CFP; 848 x 848 pixels; nonmydriatic fundus photograph — 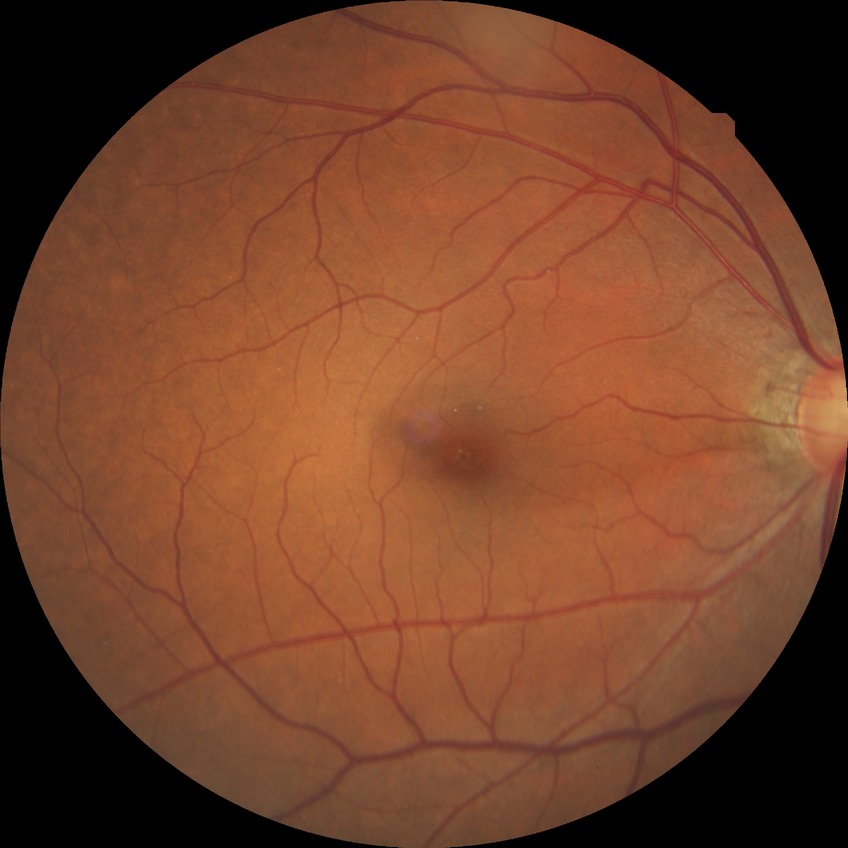

Modified Davis grading: no diabetic retinopathy.